Wide-field fundus photograph from neonatal ROP screening — 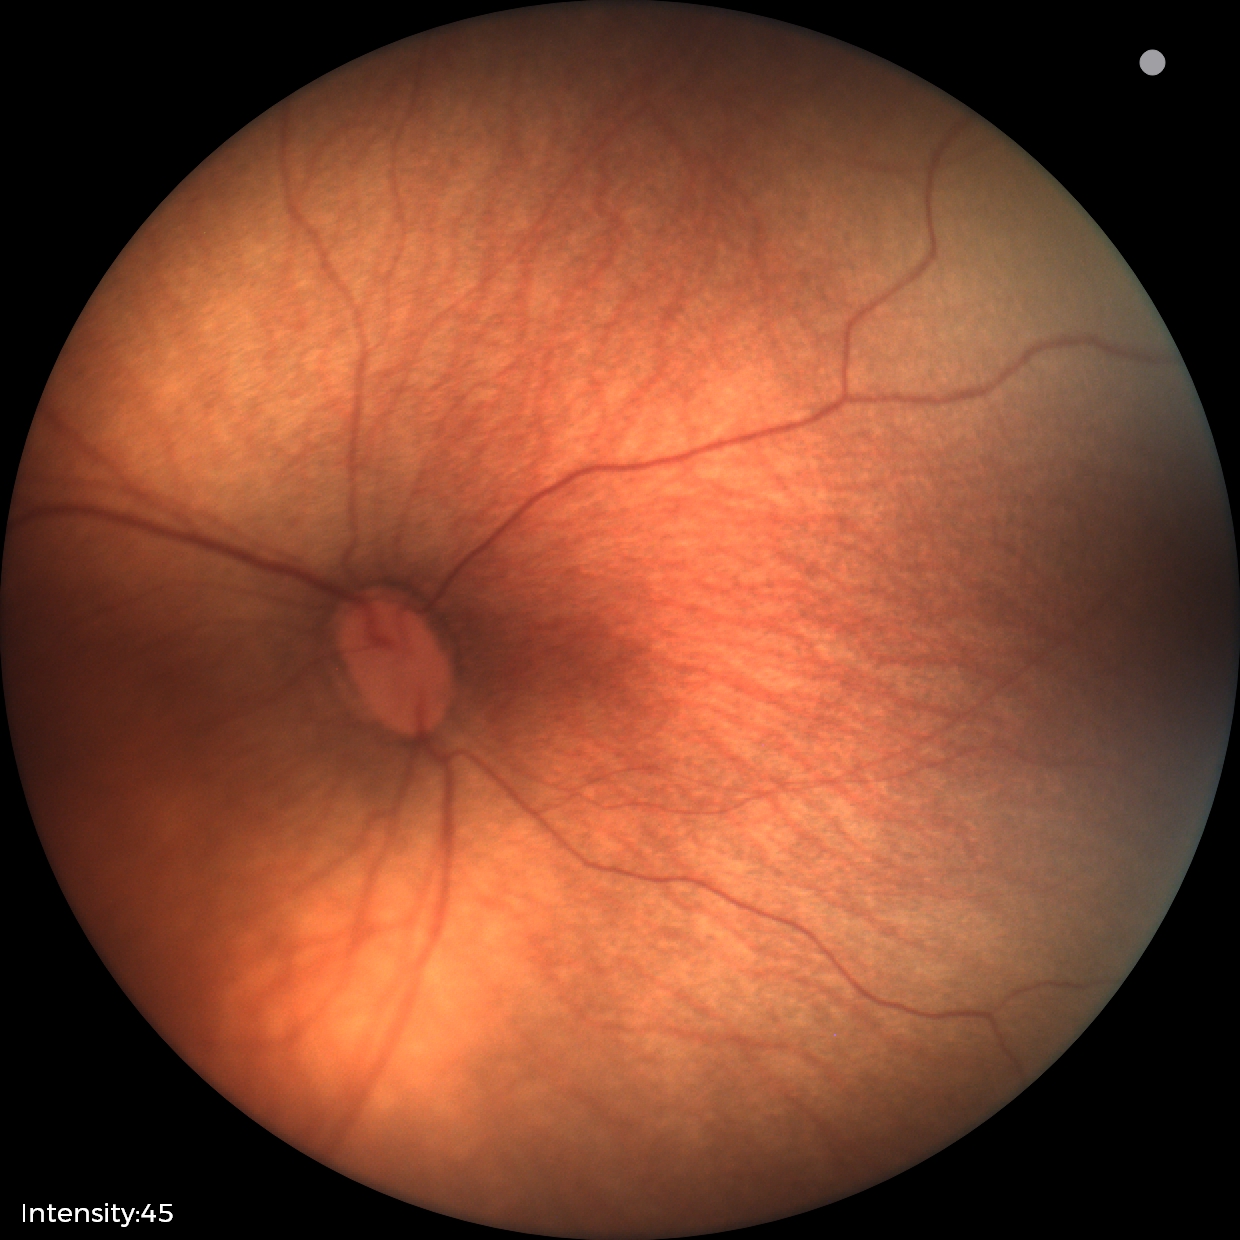
Screening examination consistent with retinopathy of prematurity (ROP) stage 1.